Field includes the optic disc and macula — 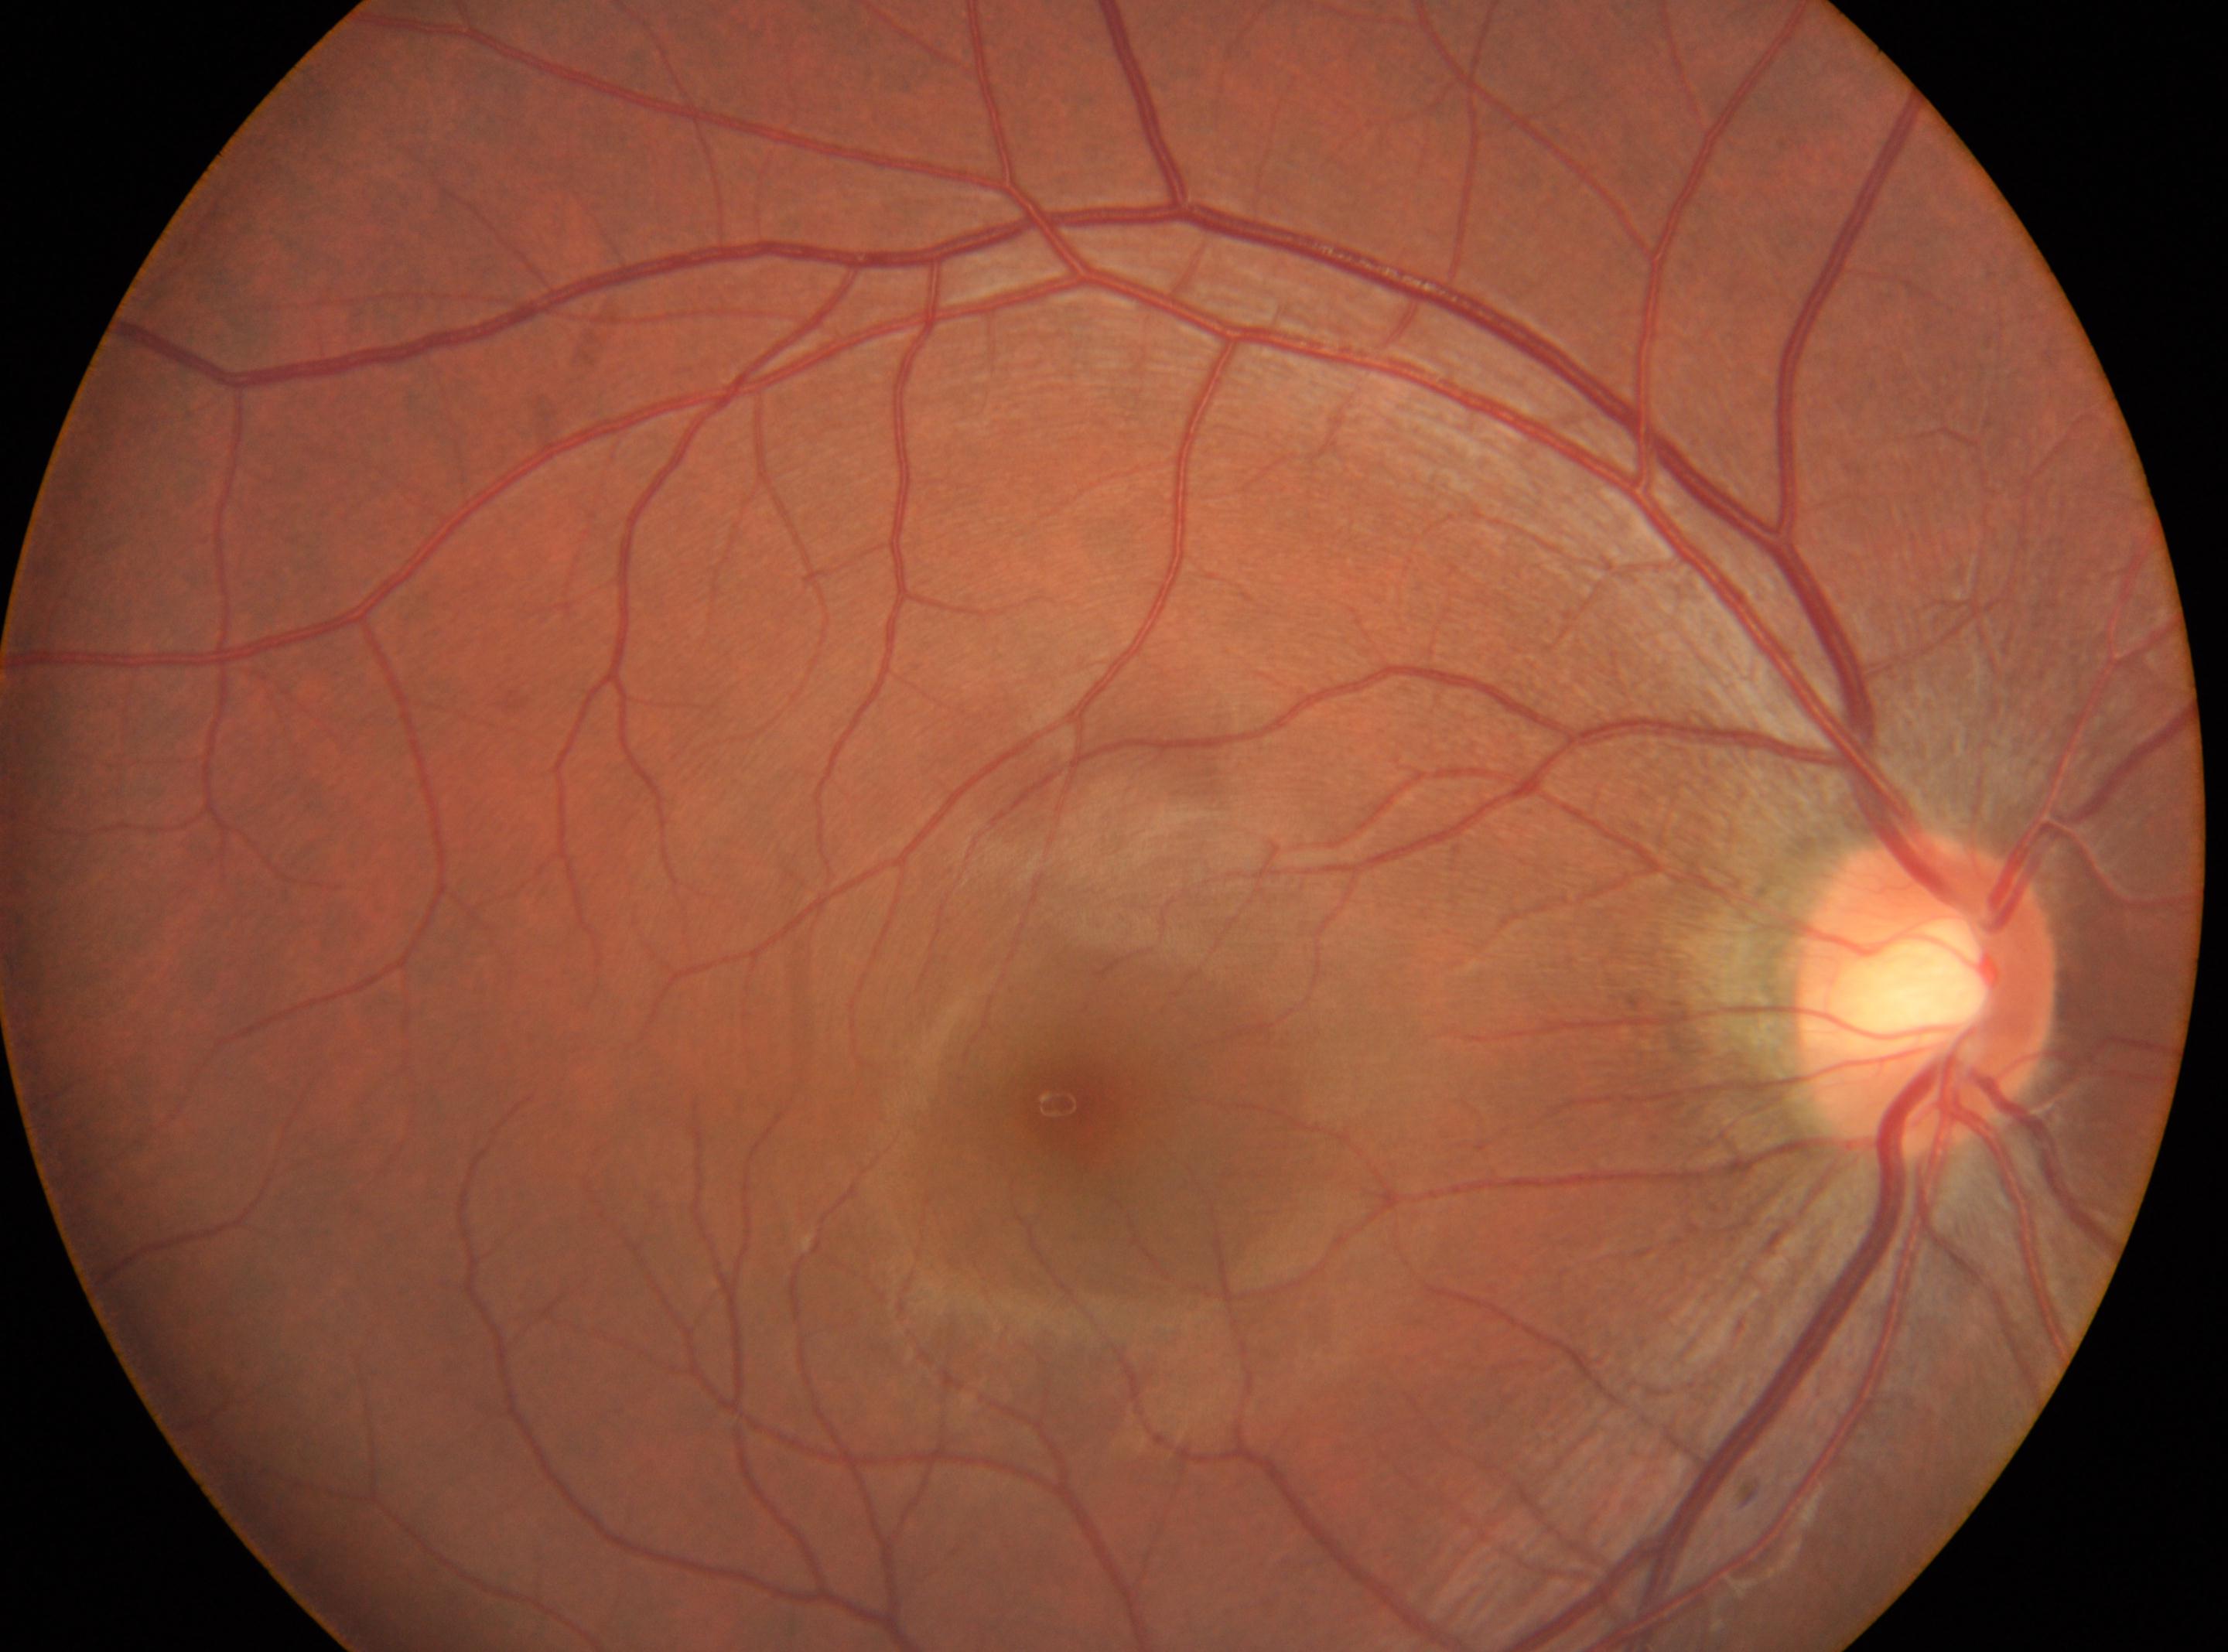

Findings:
* the fovea — (x: 1064, y: 1104)
* laterality — right eye
* disc center — (x: 1927, y: 994)
* DR impression — No signs of diabetic retinopathy
* DR stage — 0/4